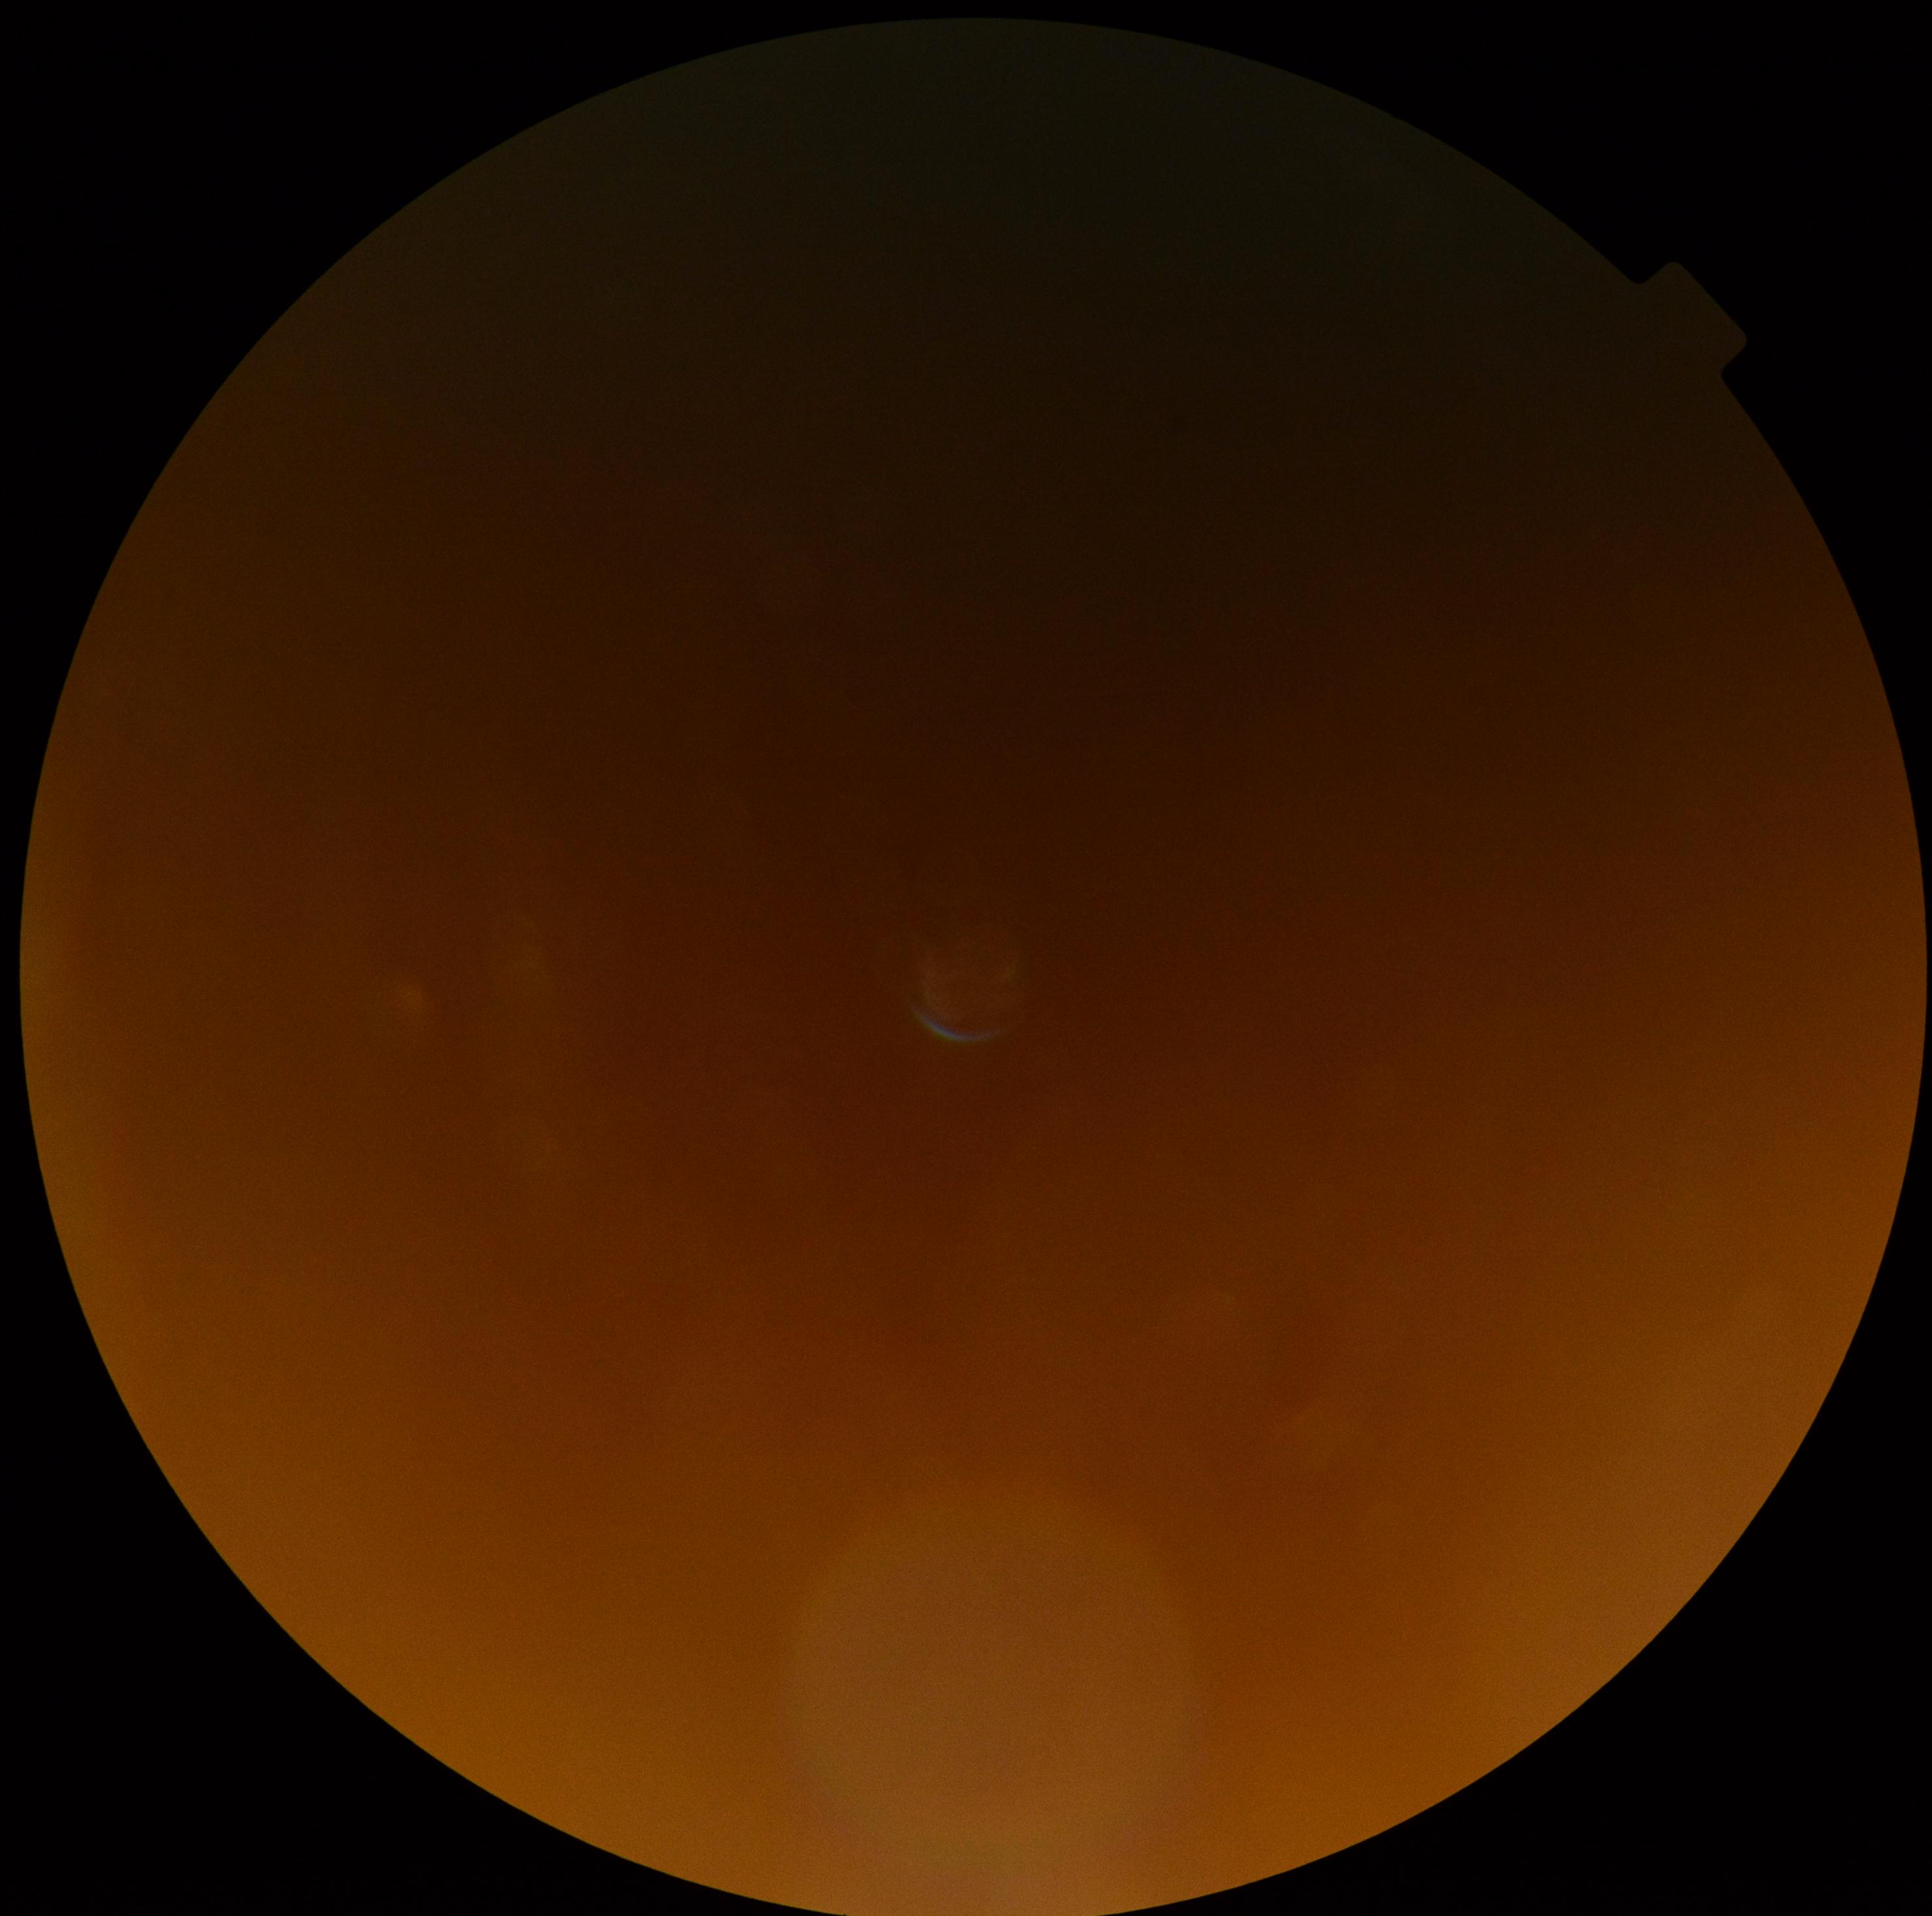
image quality@below grading threshold; diabetic retinopathy (DR)@ungradable due to poor image quality.